Captured without pupil dilation. Nidek AFC-330: 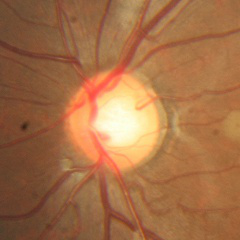 Q: What stage of glaucoma is present?
A: No — no signs of glaucoma.